Image size 2352x1568.
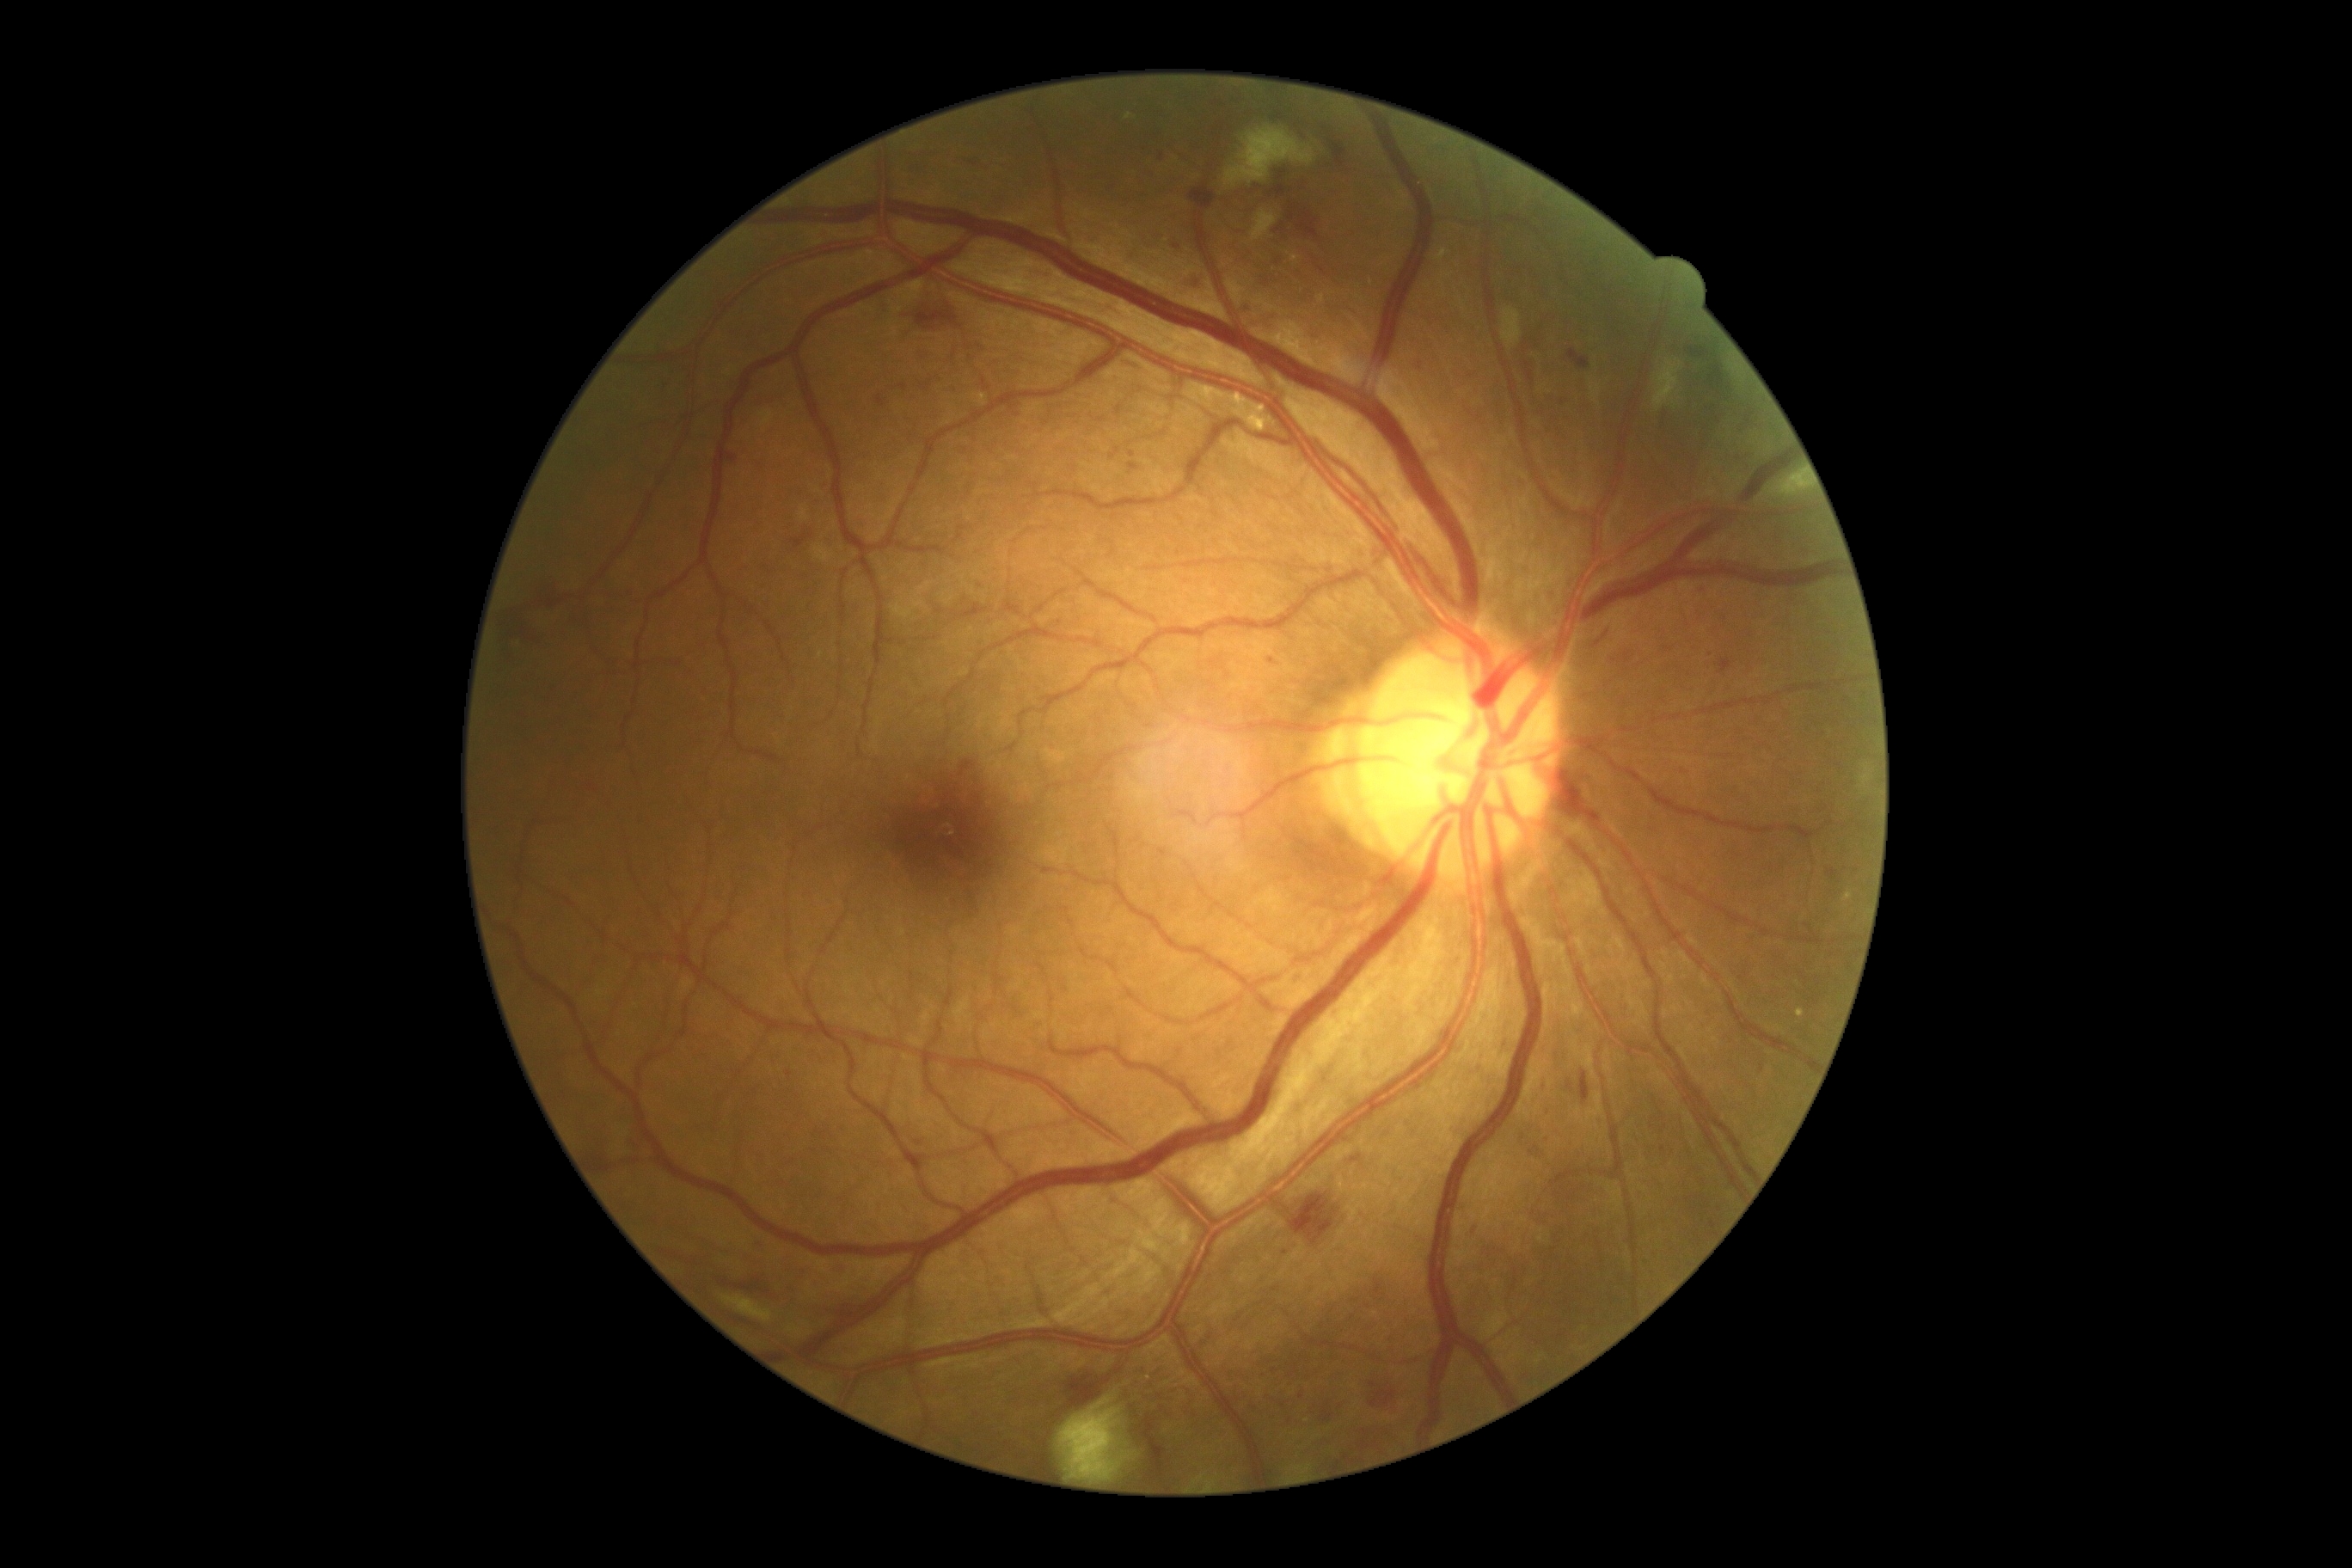

DR grade: 2/4.
Disease class: non-proliferative diabetic retinopathy.